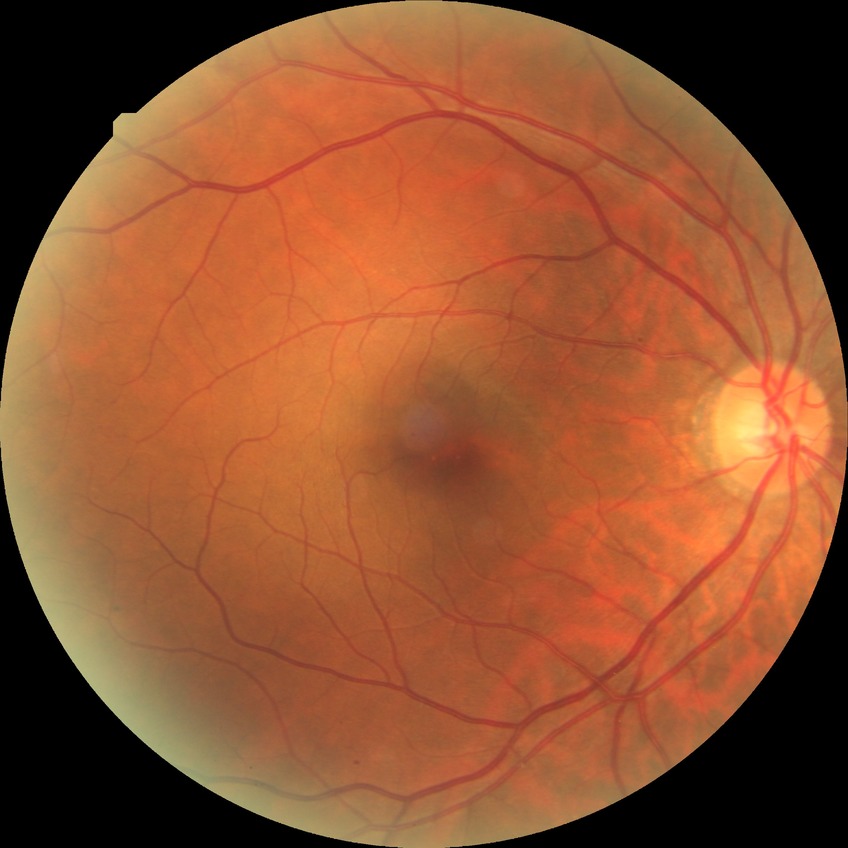
{"proliferative_class": "non-proliferative diabetic retinopathy", "davis_grade": "SDR"}